Image size 2212x1659; FOV: 45 degrees.
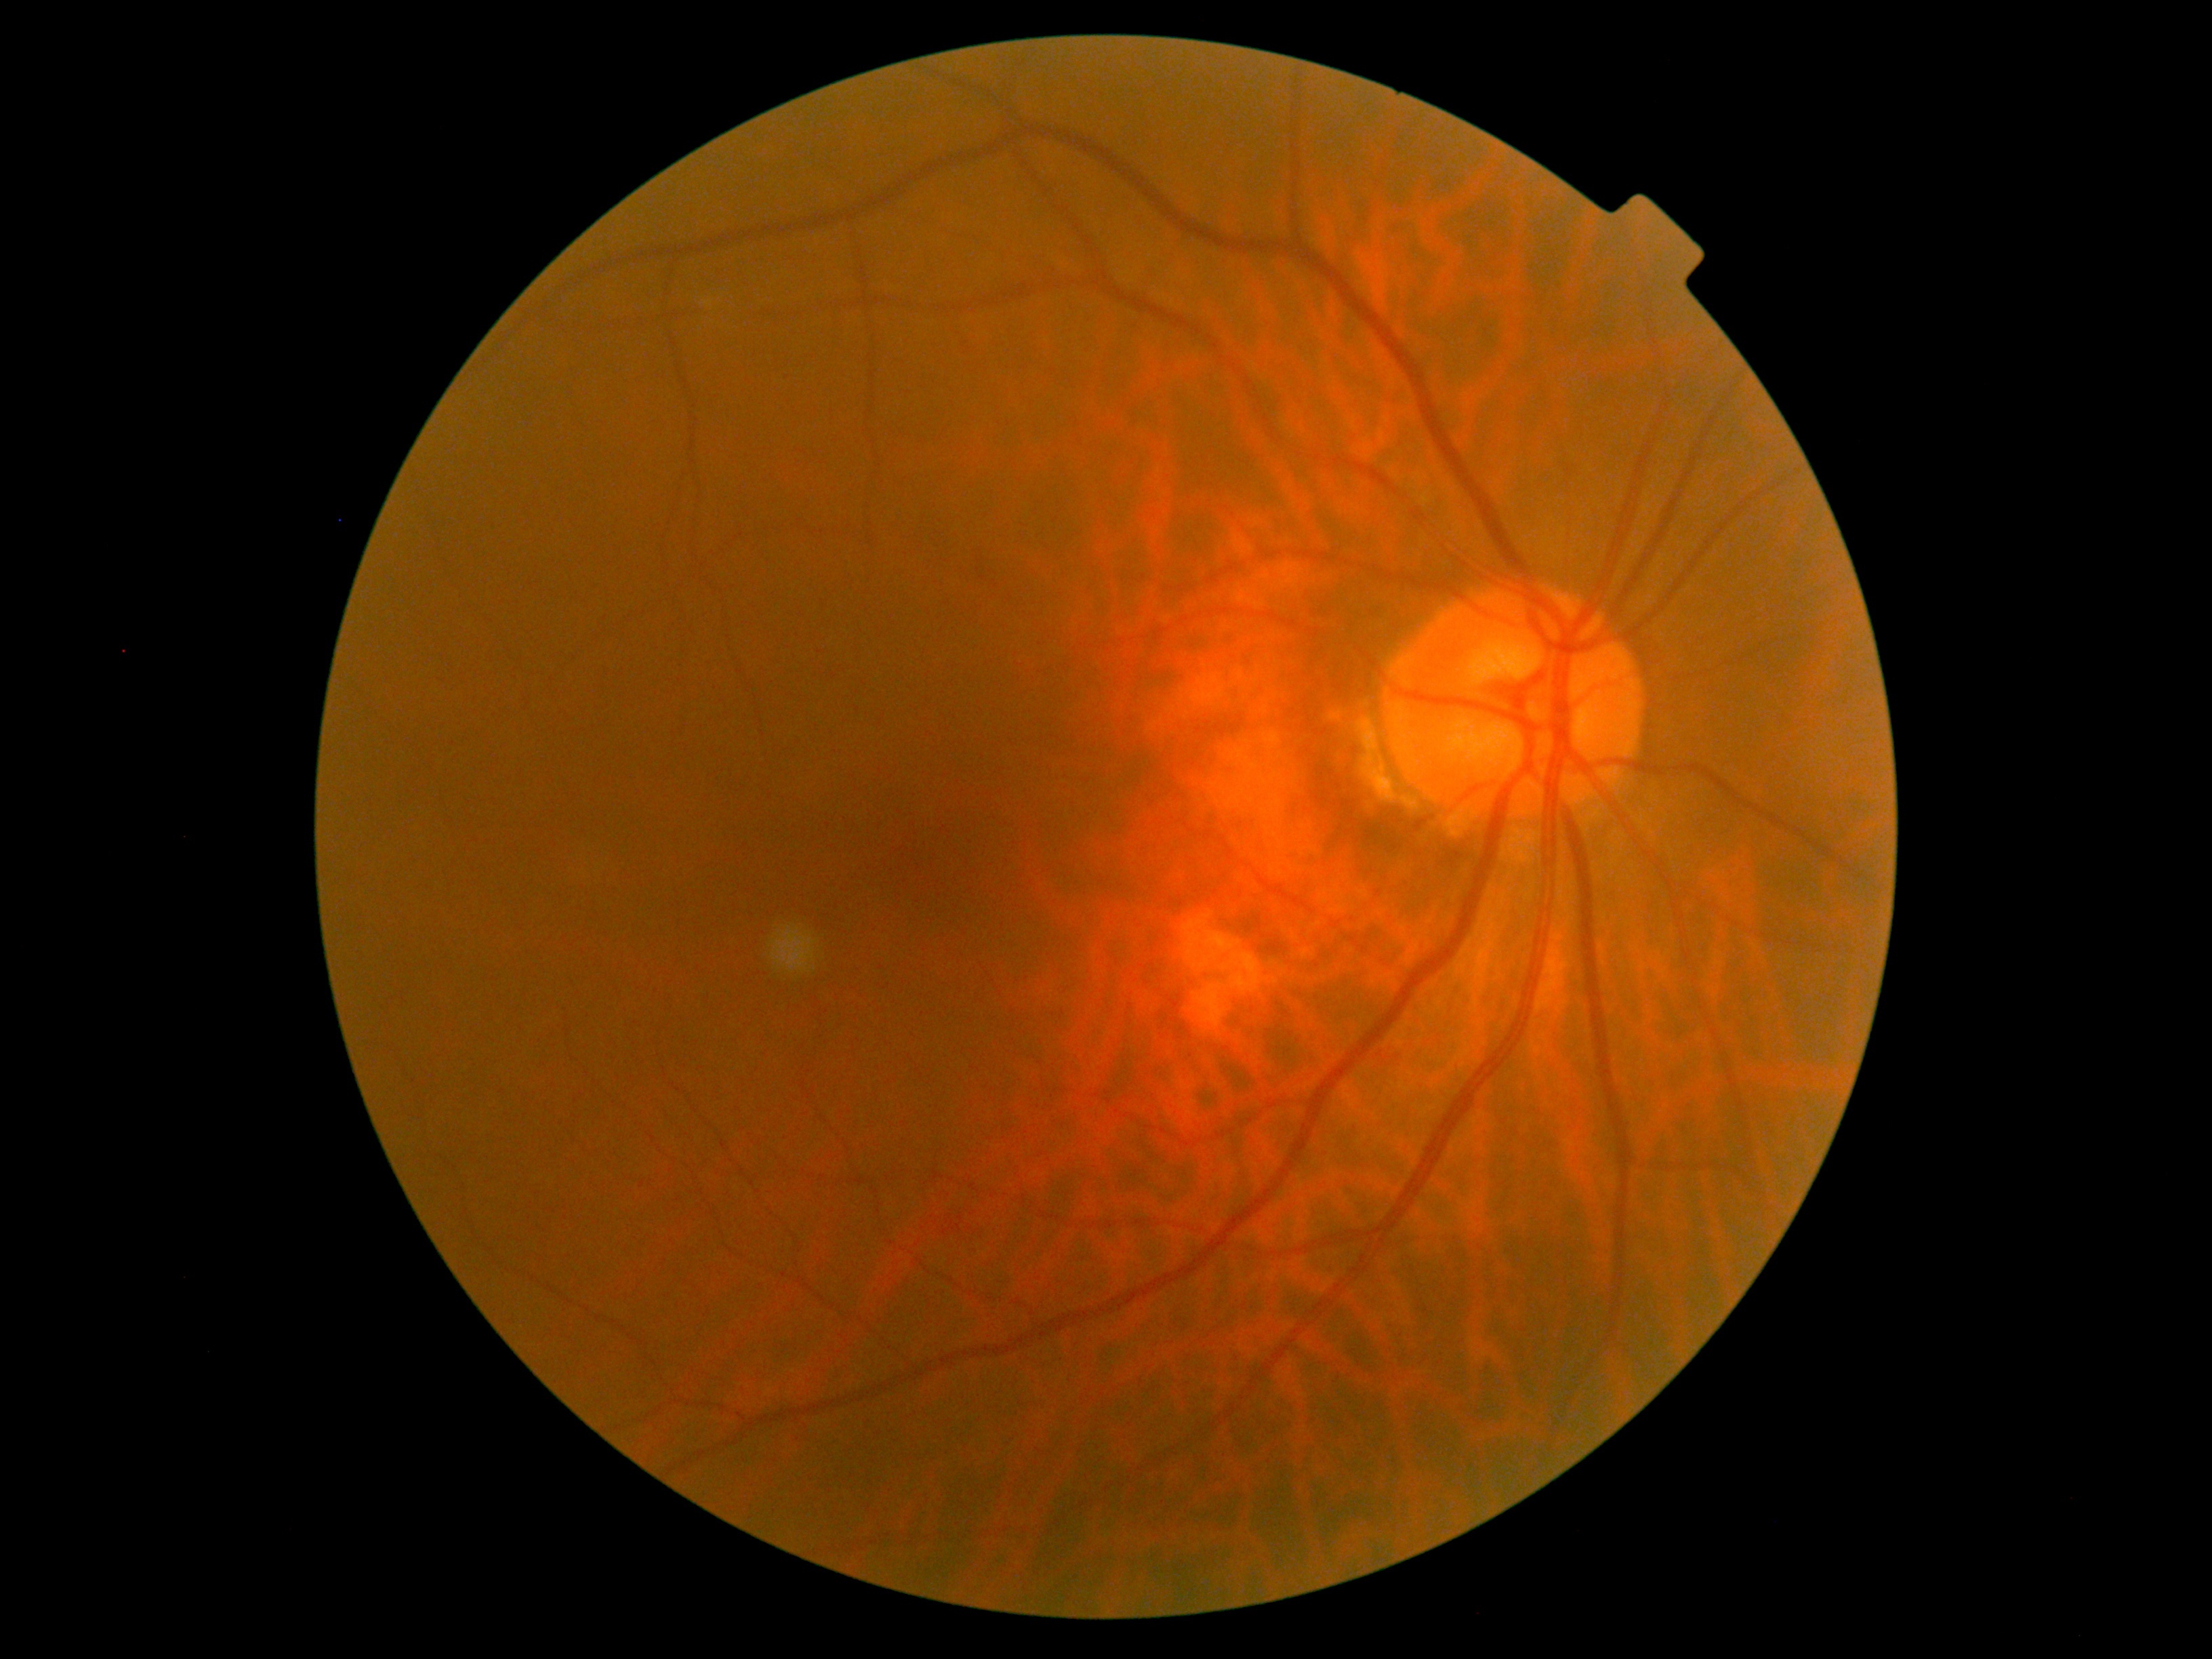

diabetic retinopathy (DR) = grade 0.